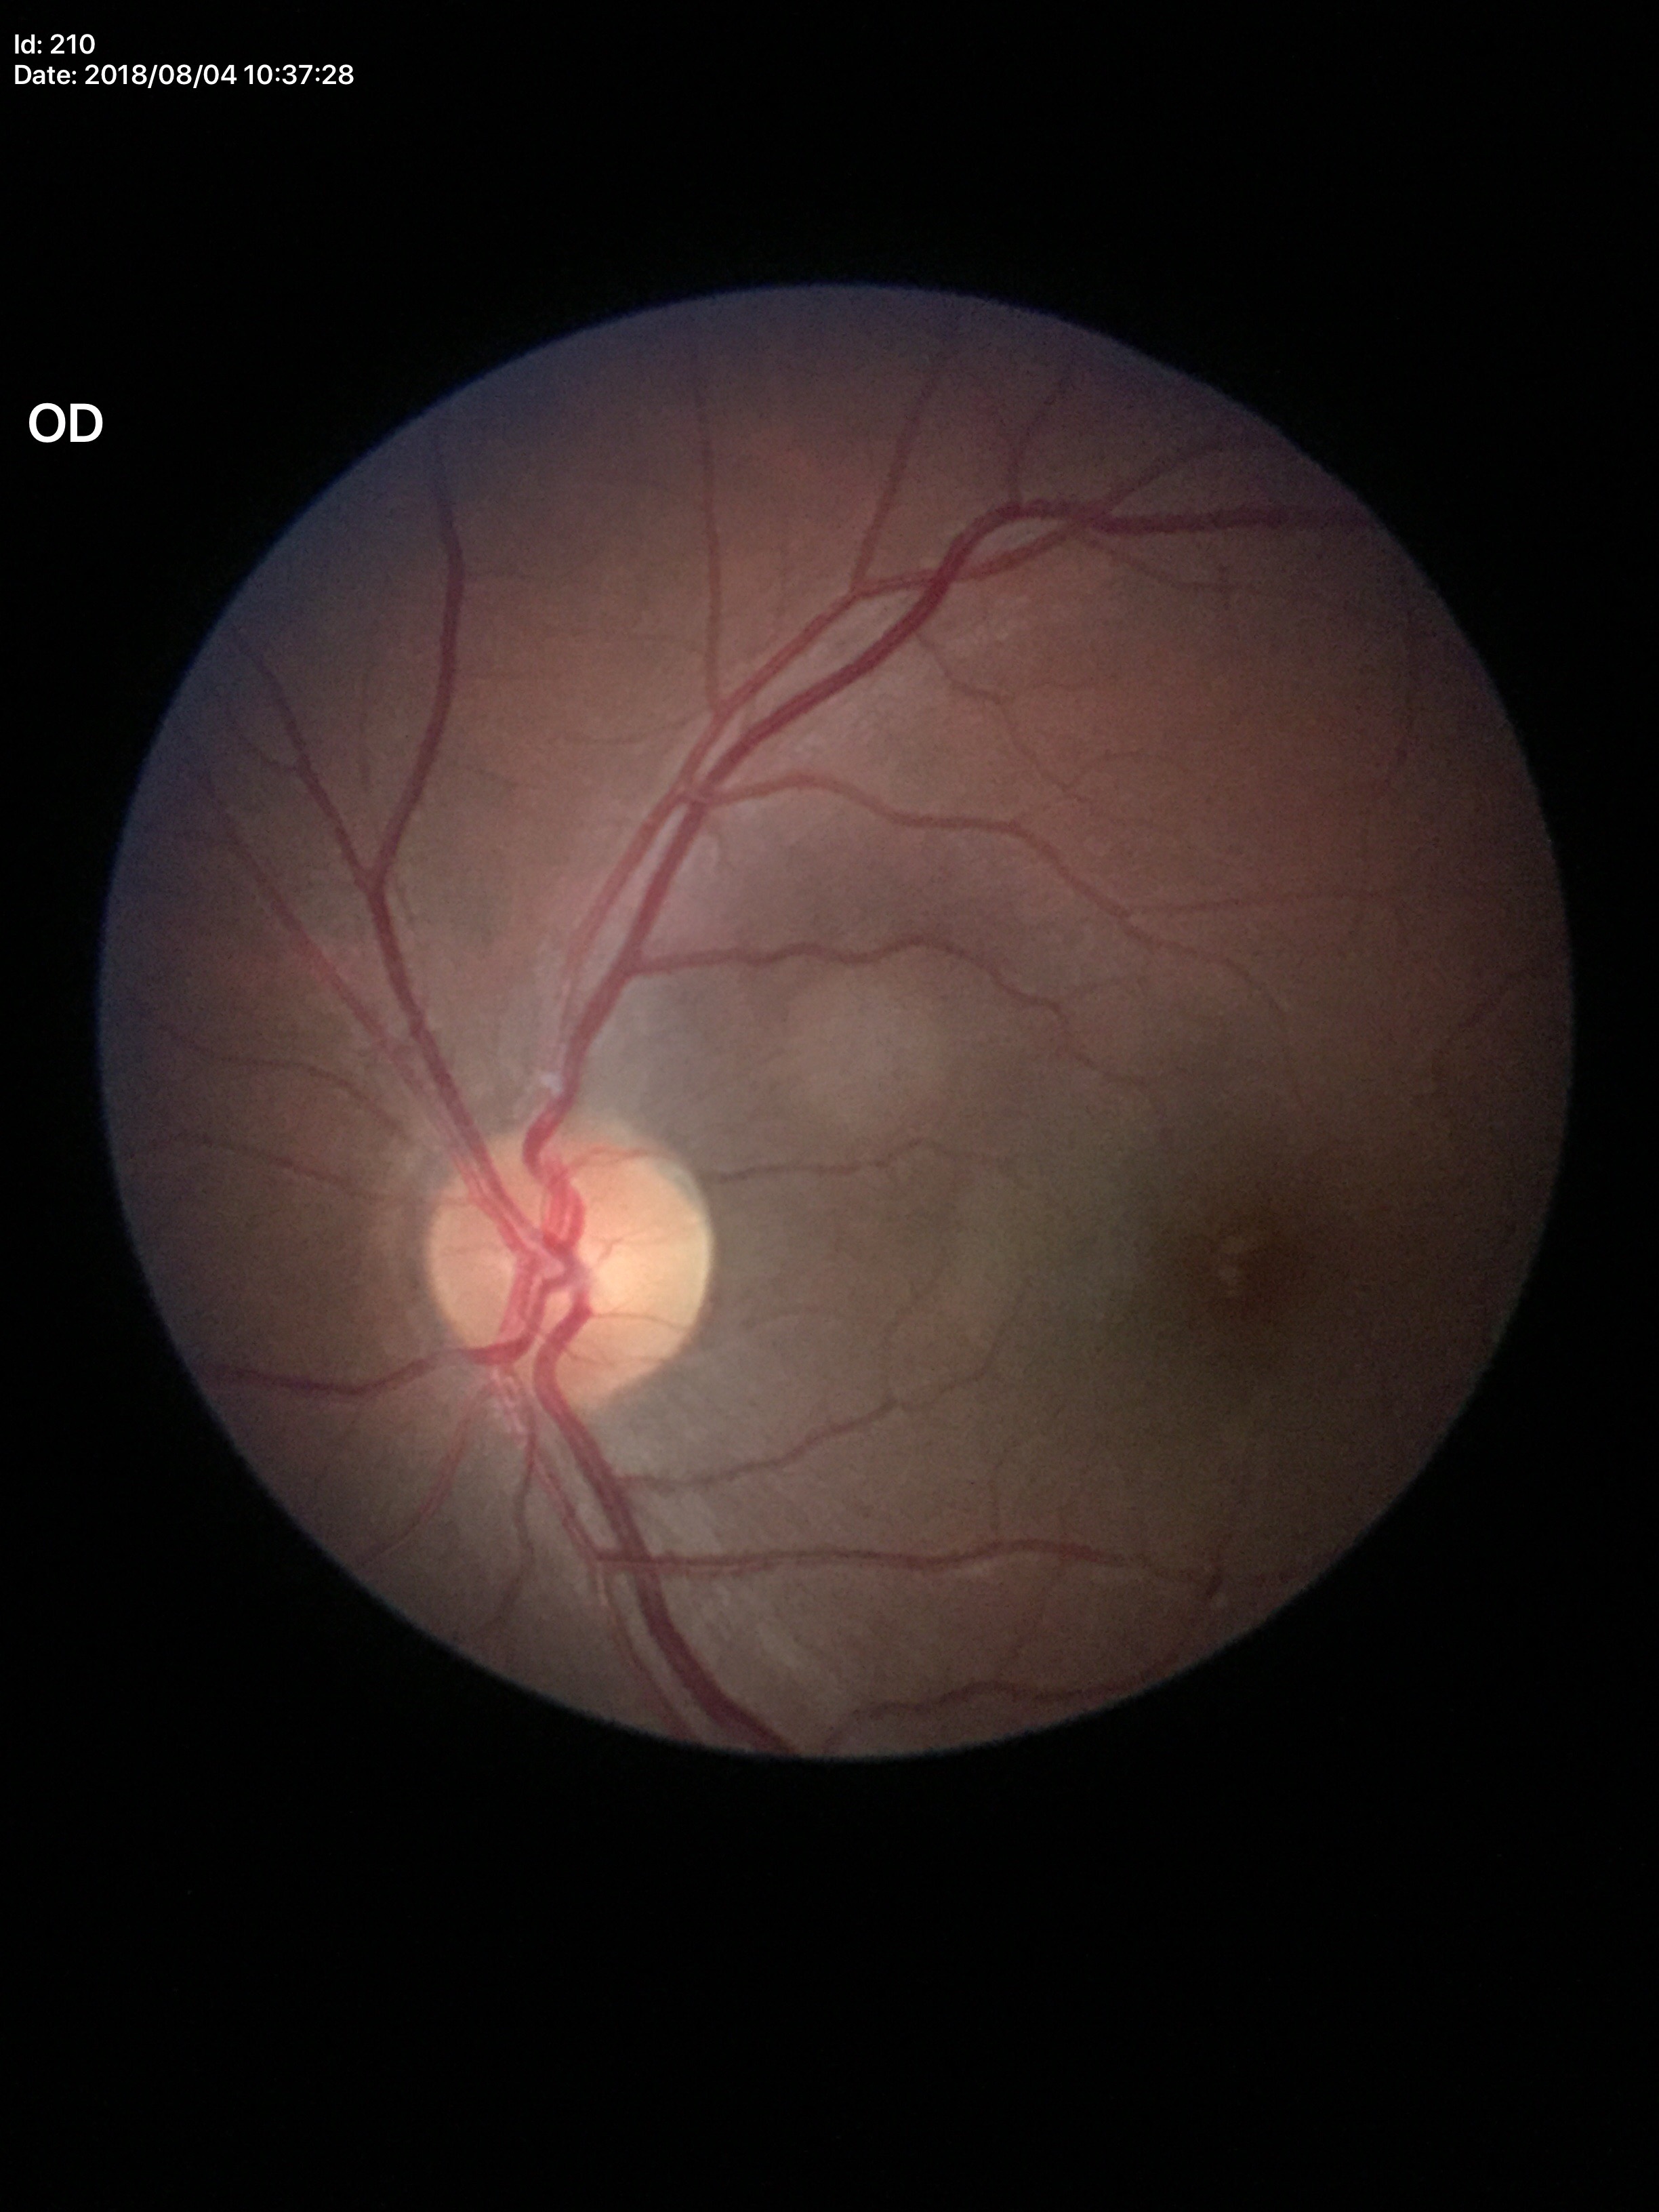

Glaucoma decision: not suspect (unanimous normal call).
Vertical cup-disc ratio (VCDR): 0.42.
Area cup-disc ratio (ACDR) is 0.21.